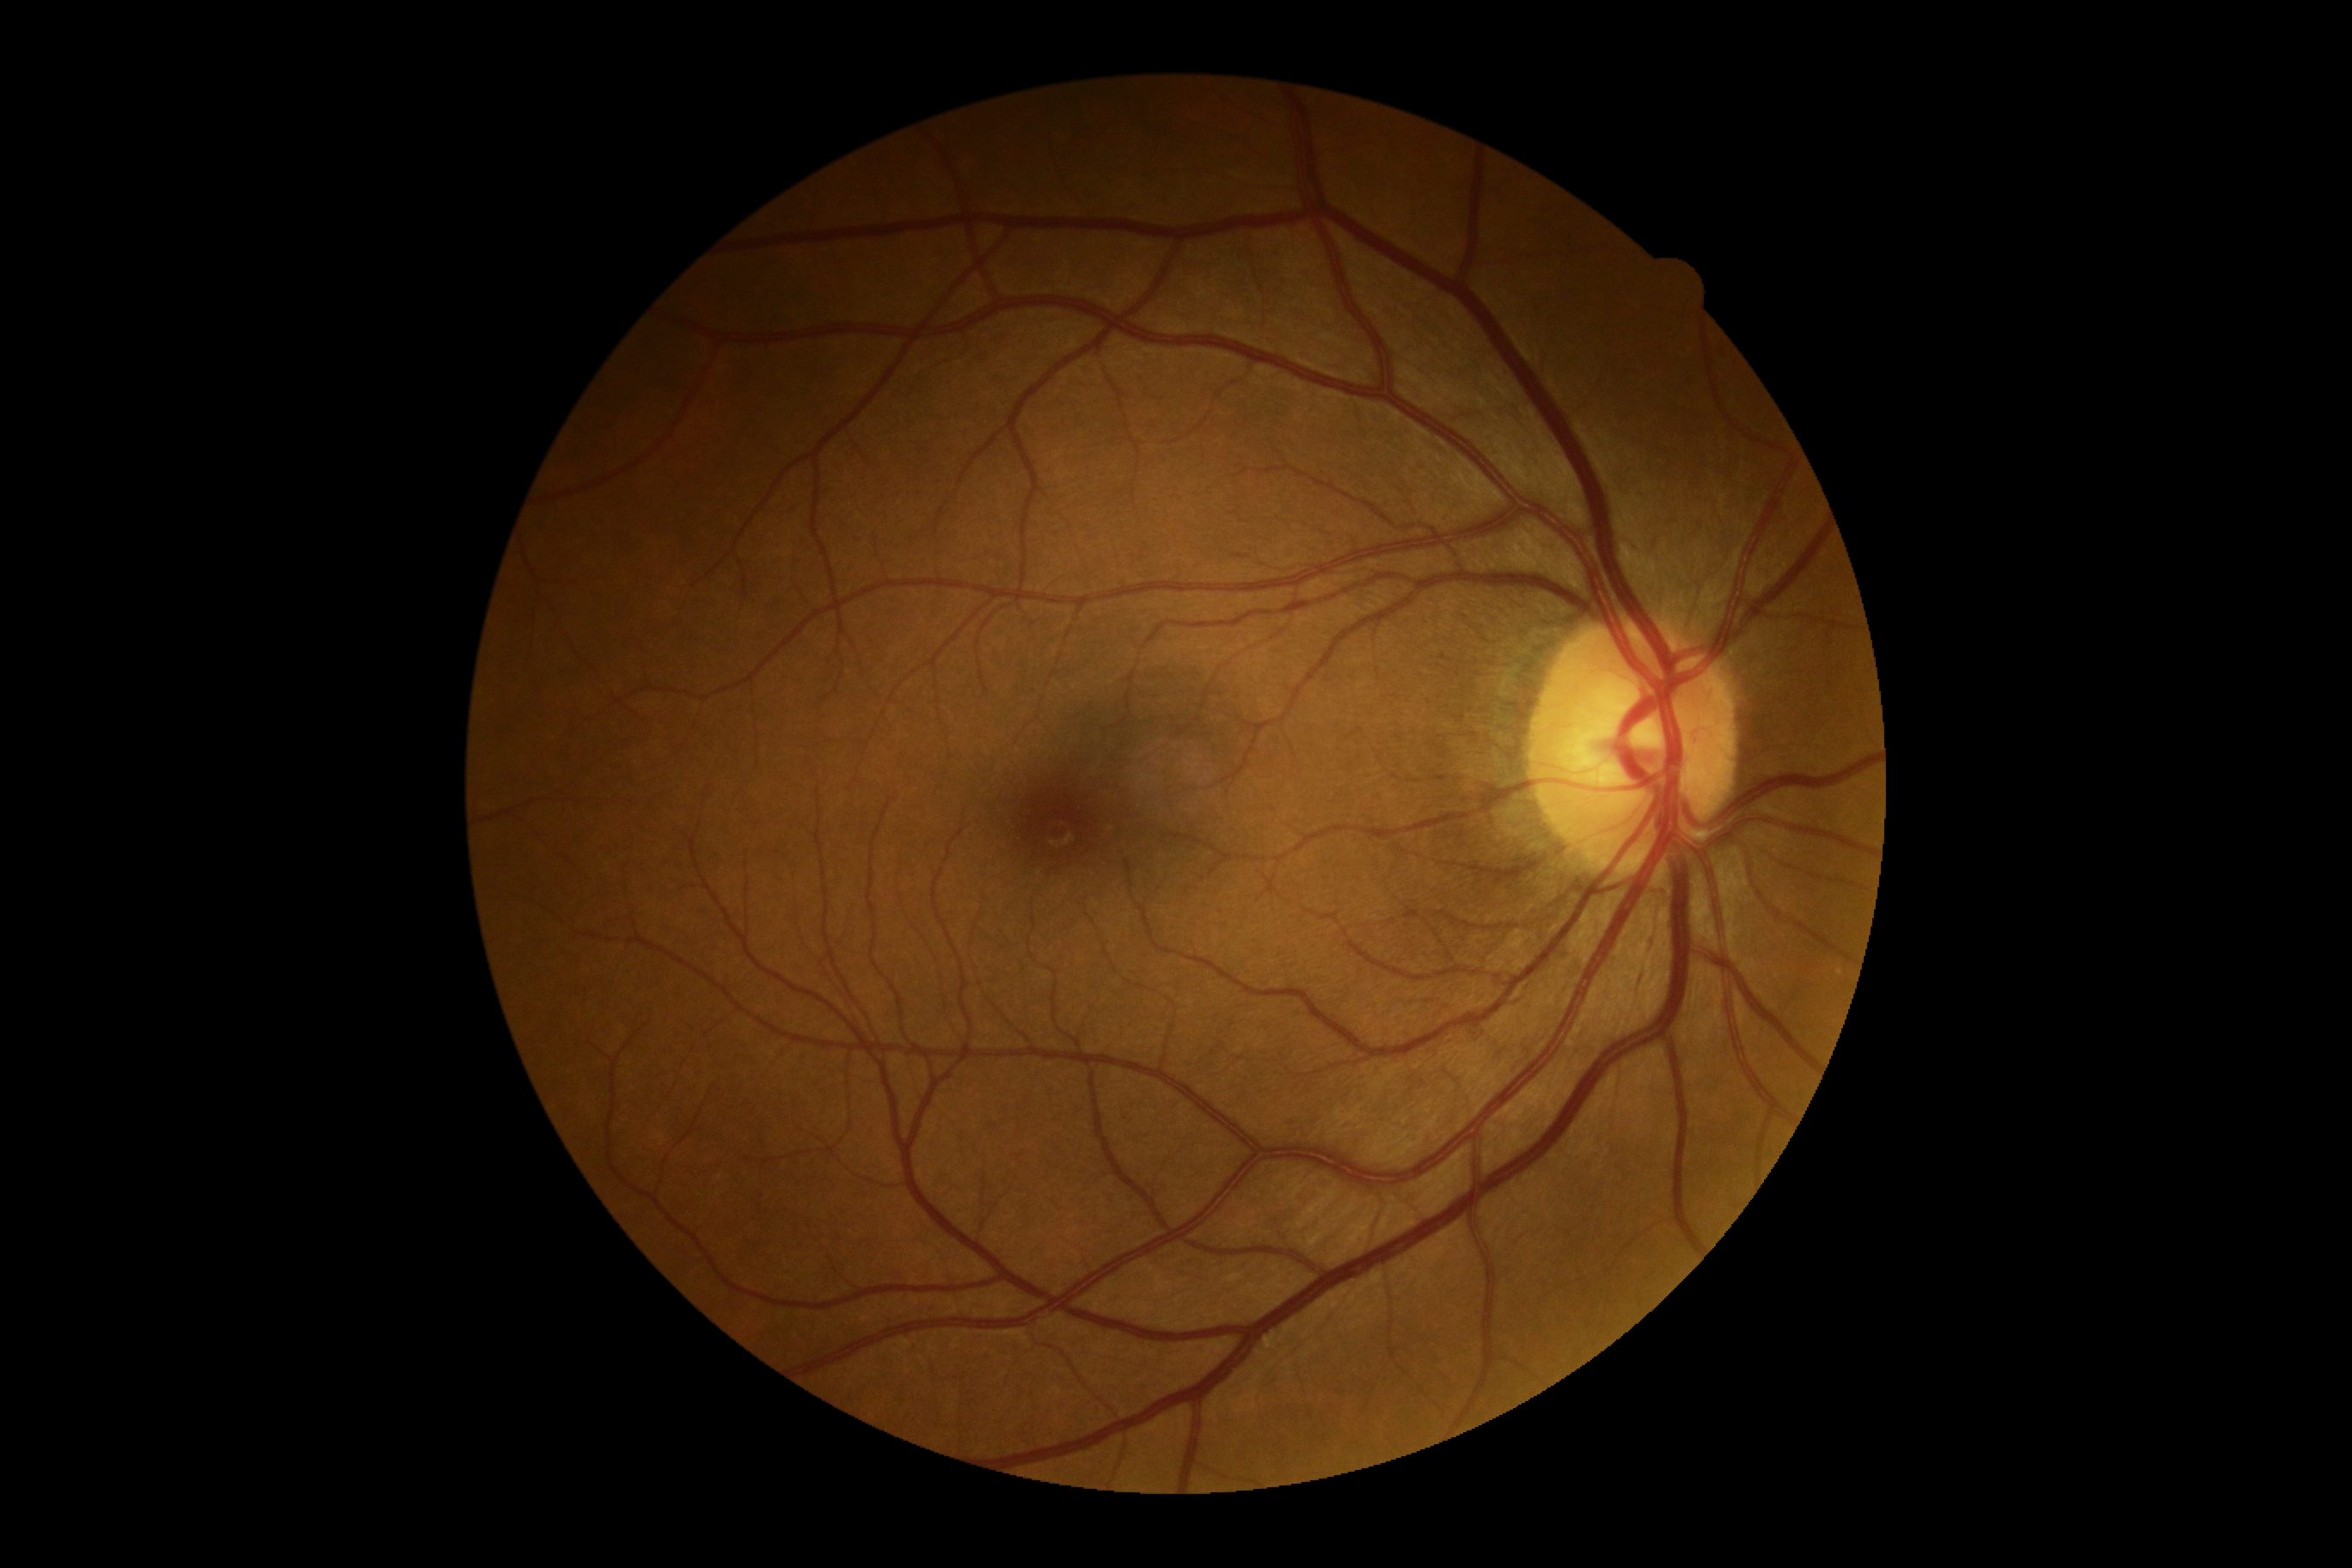 DR grade: no apparent diabetic retinopathy (0).